2352 by 1568 pixels: 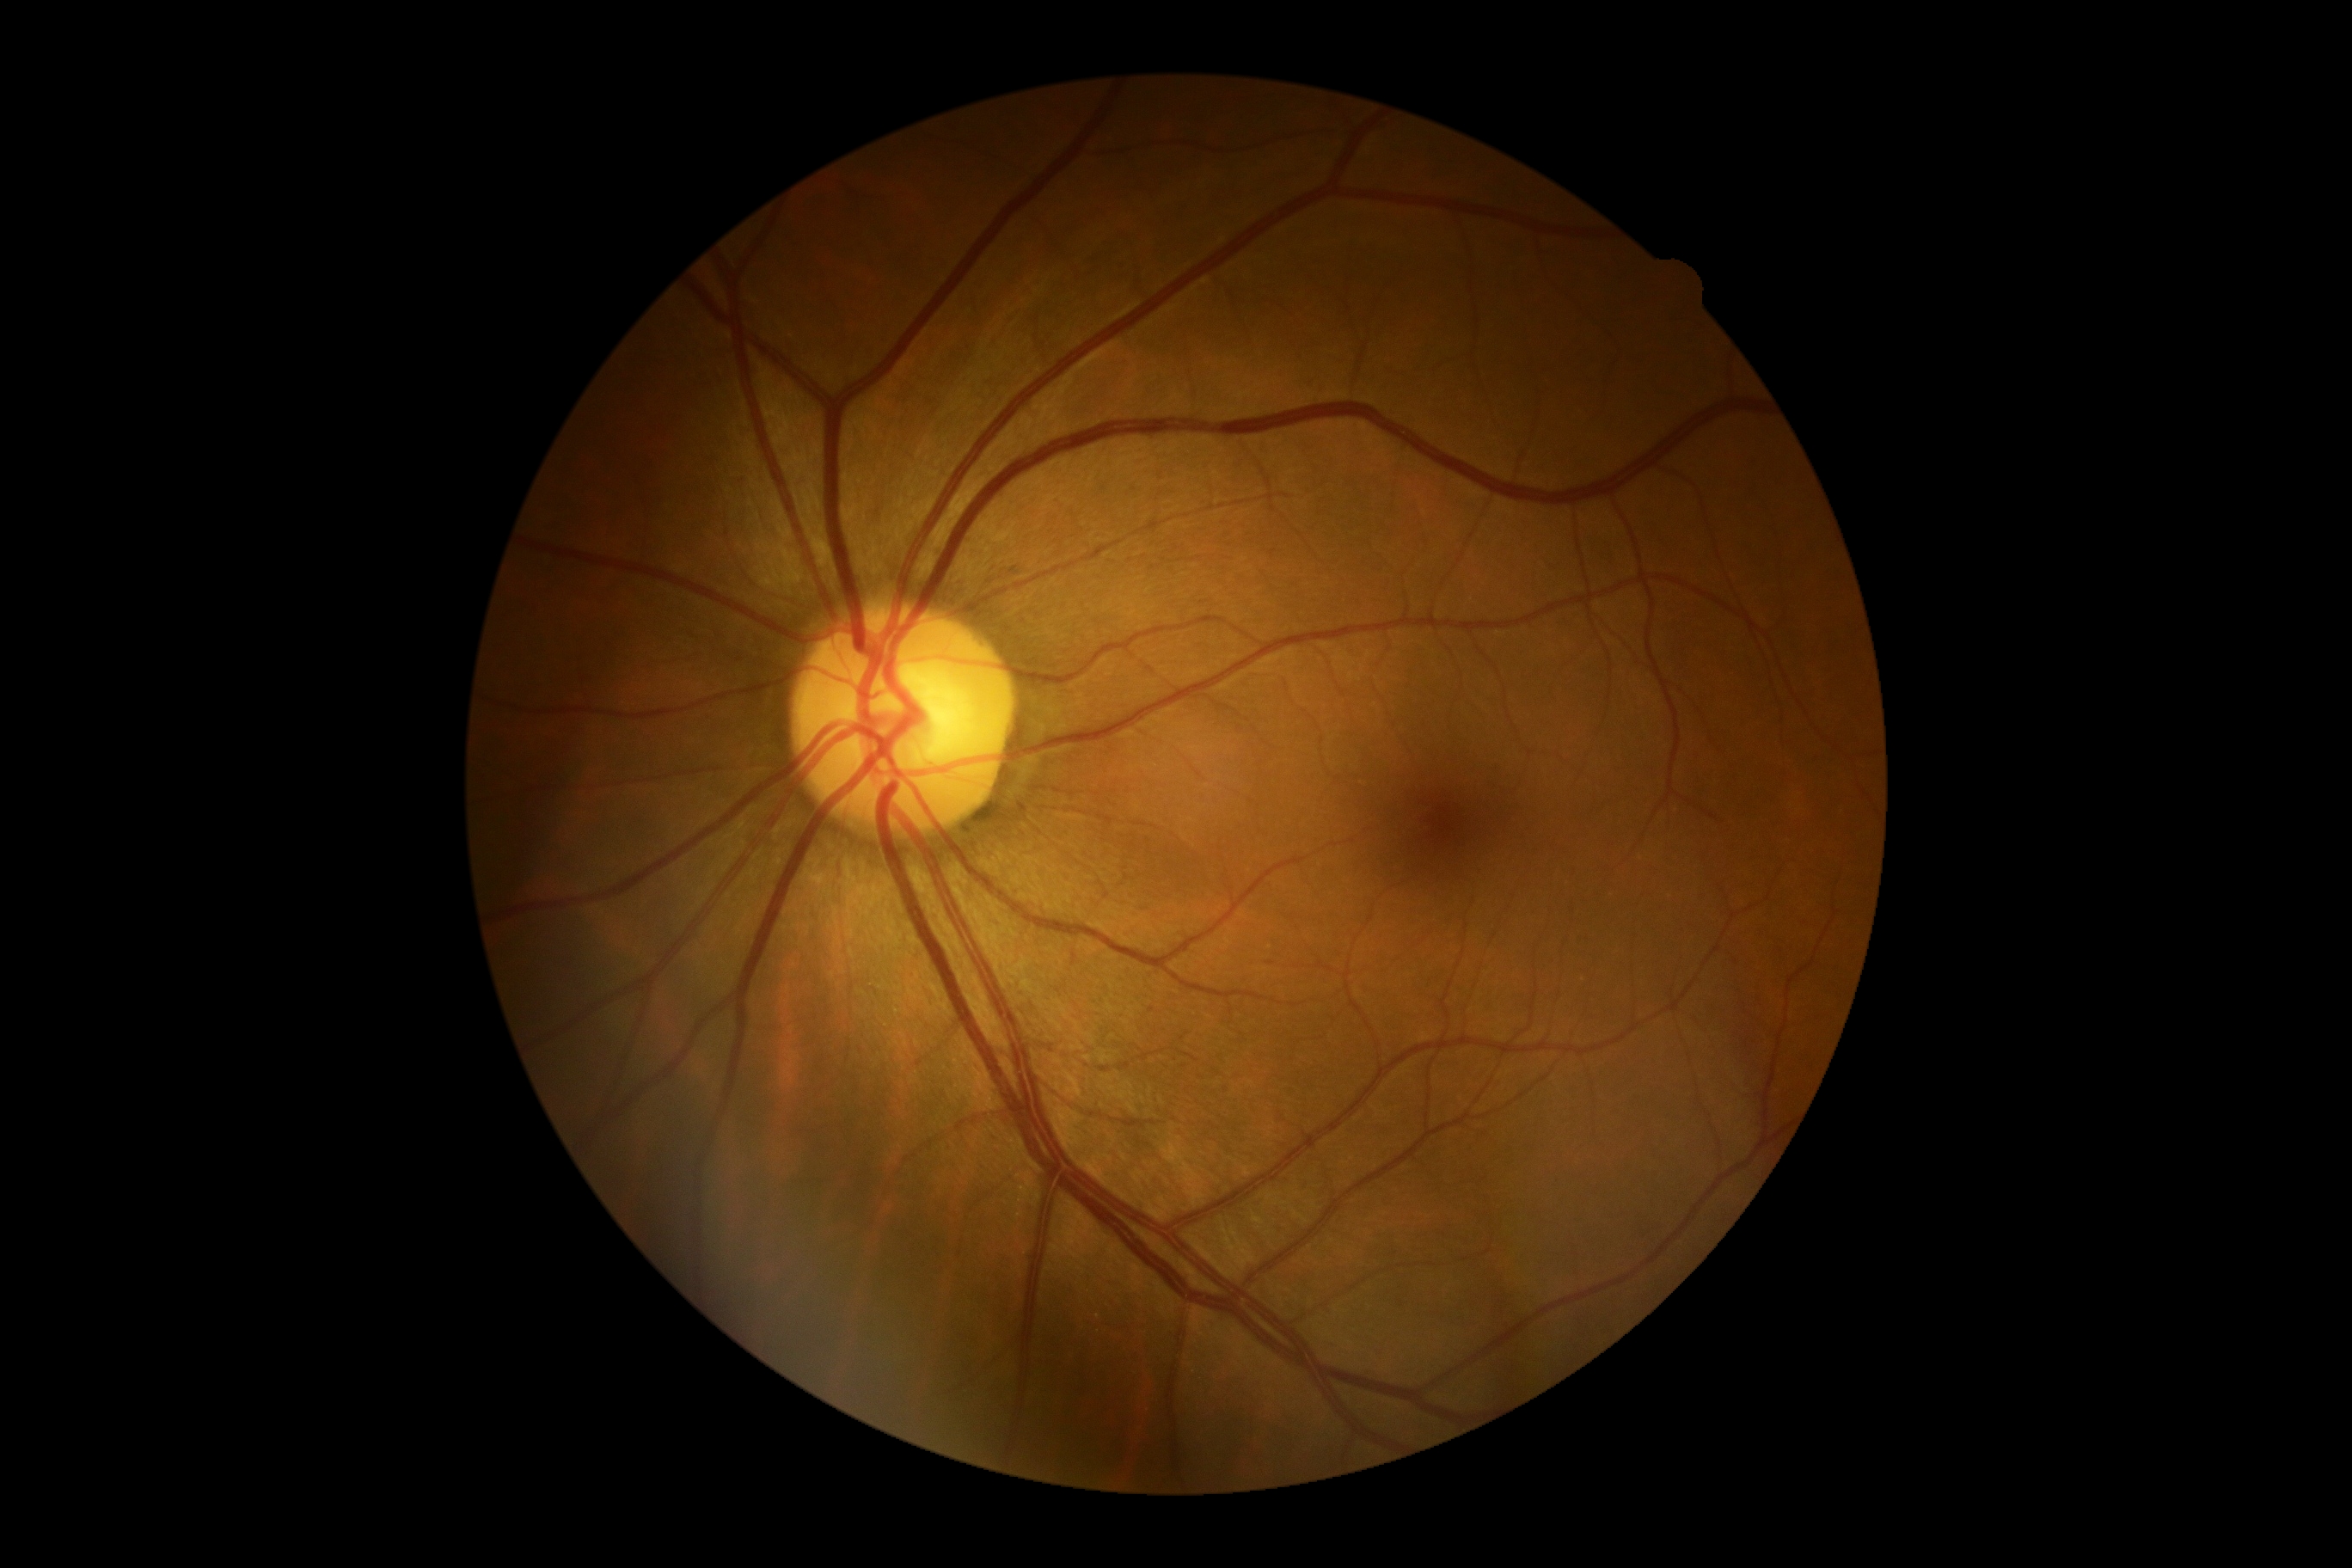
Retinopathy: no apparent retinopathy (grade 0).